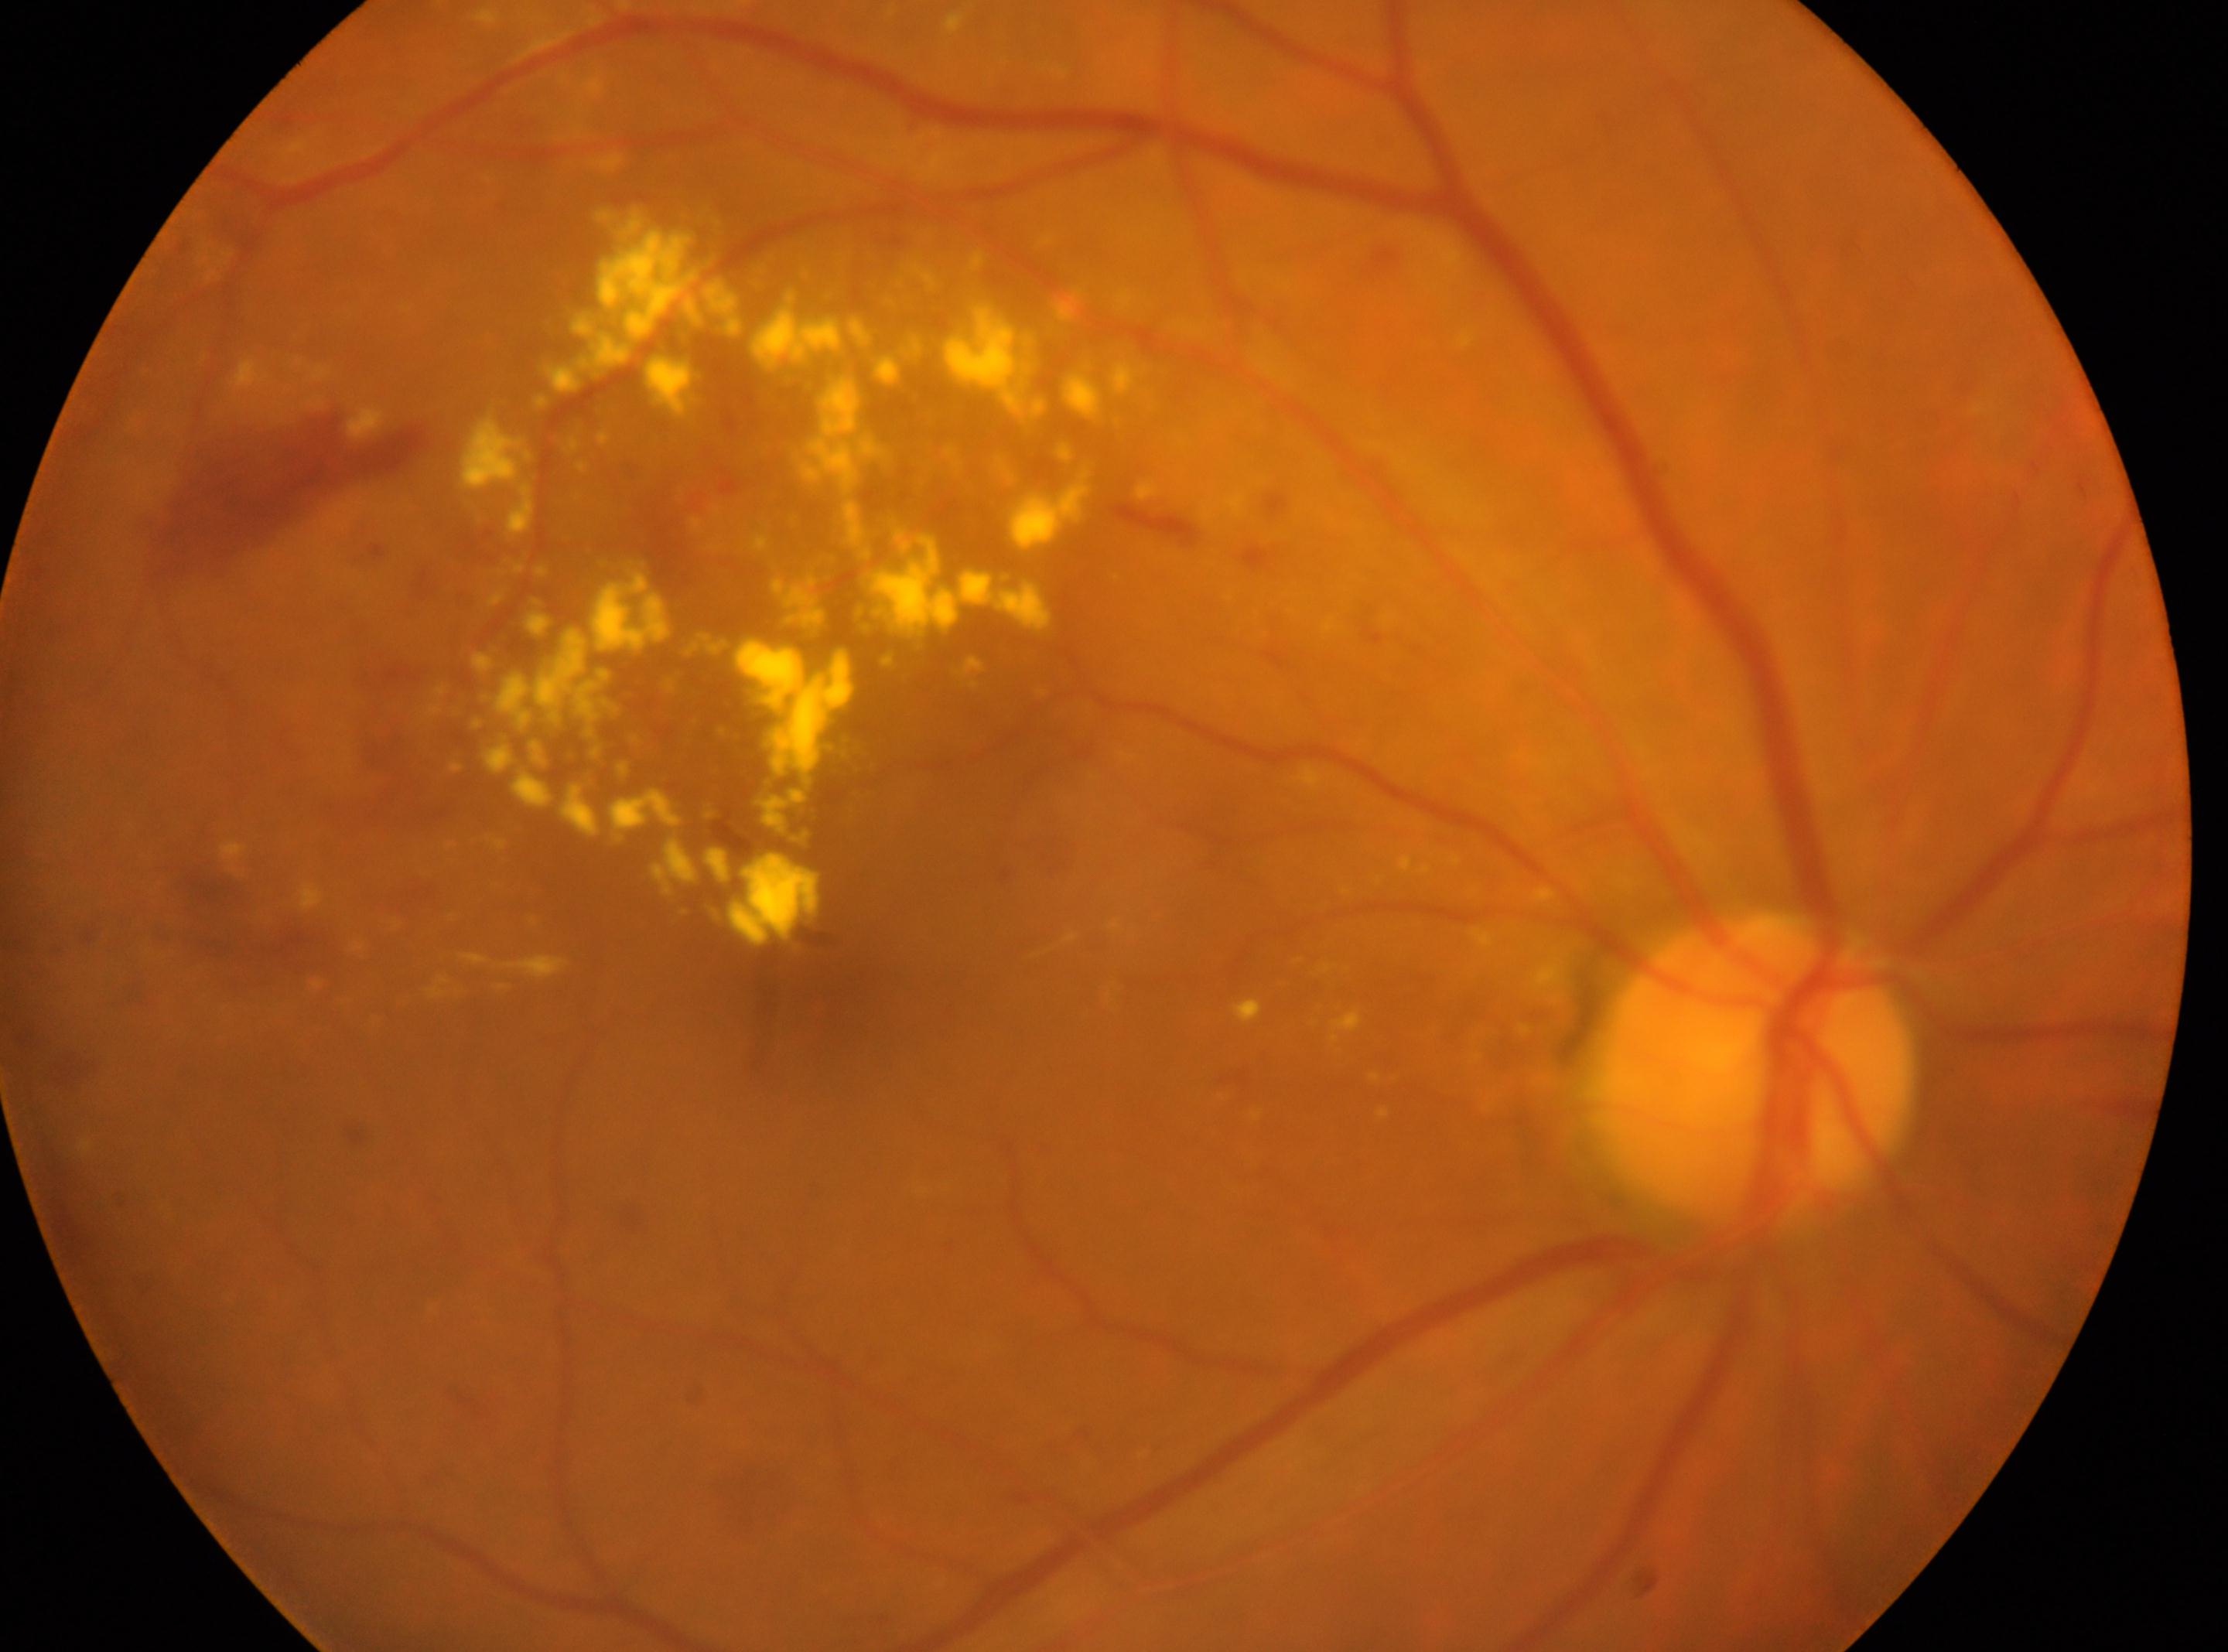 OD
foveal center: [817, 1005]
disc center: [1755, 1069]
retinopathy: grade 2 — more than just microaneurysms but less than severe NPDR